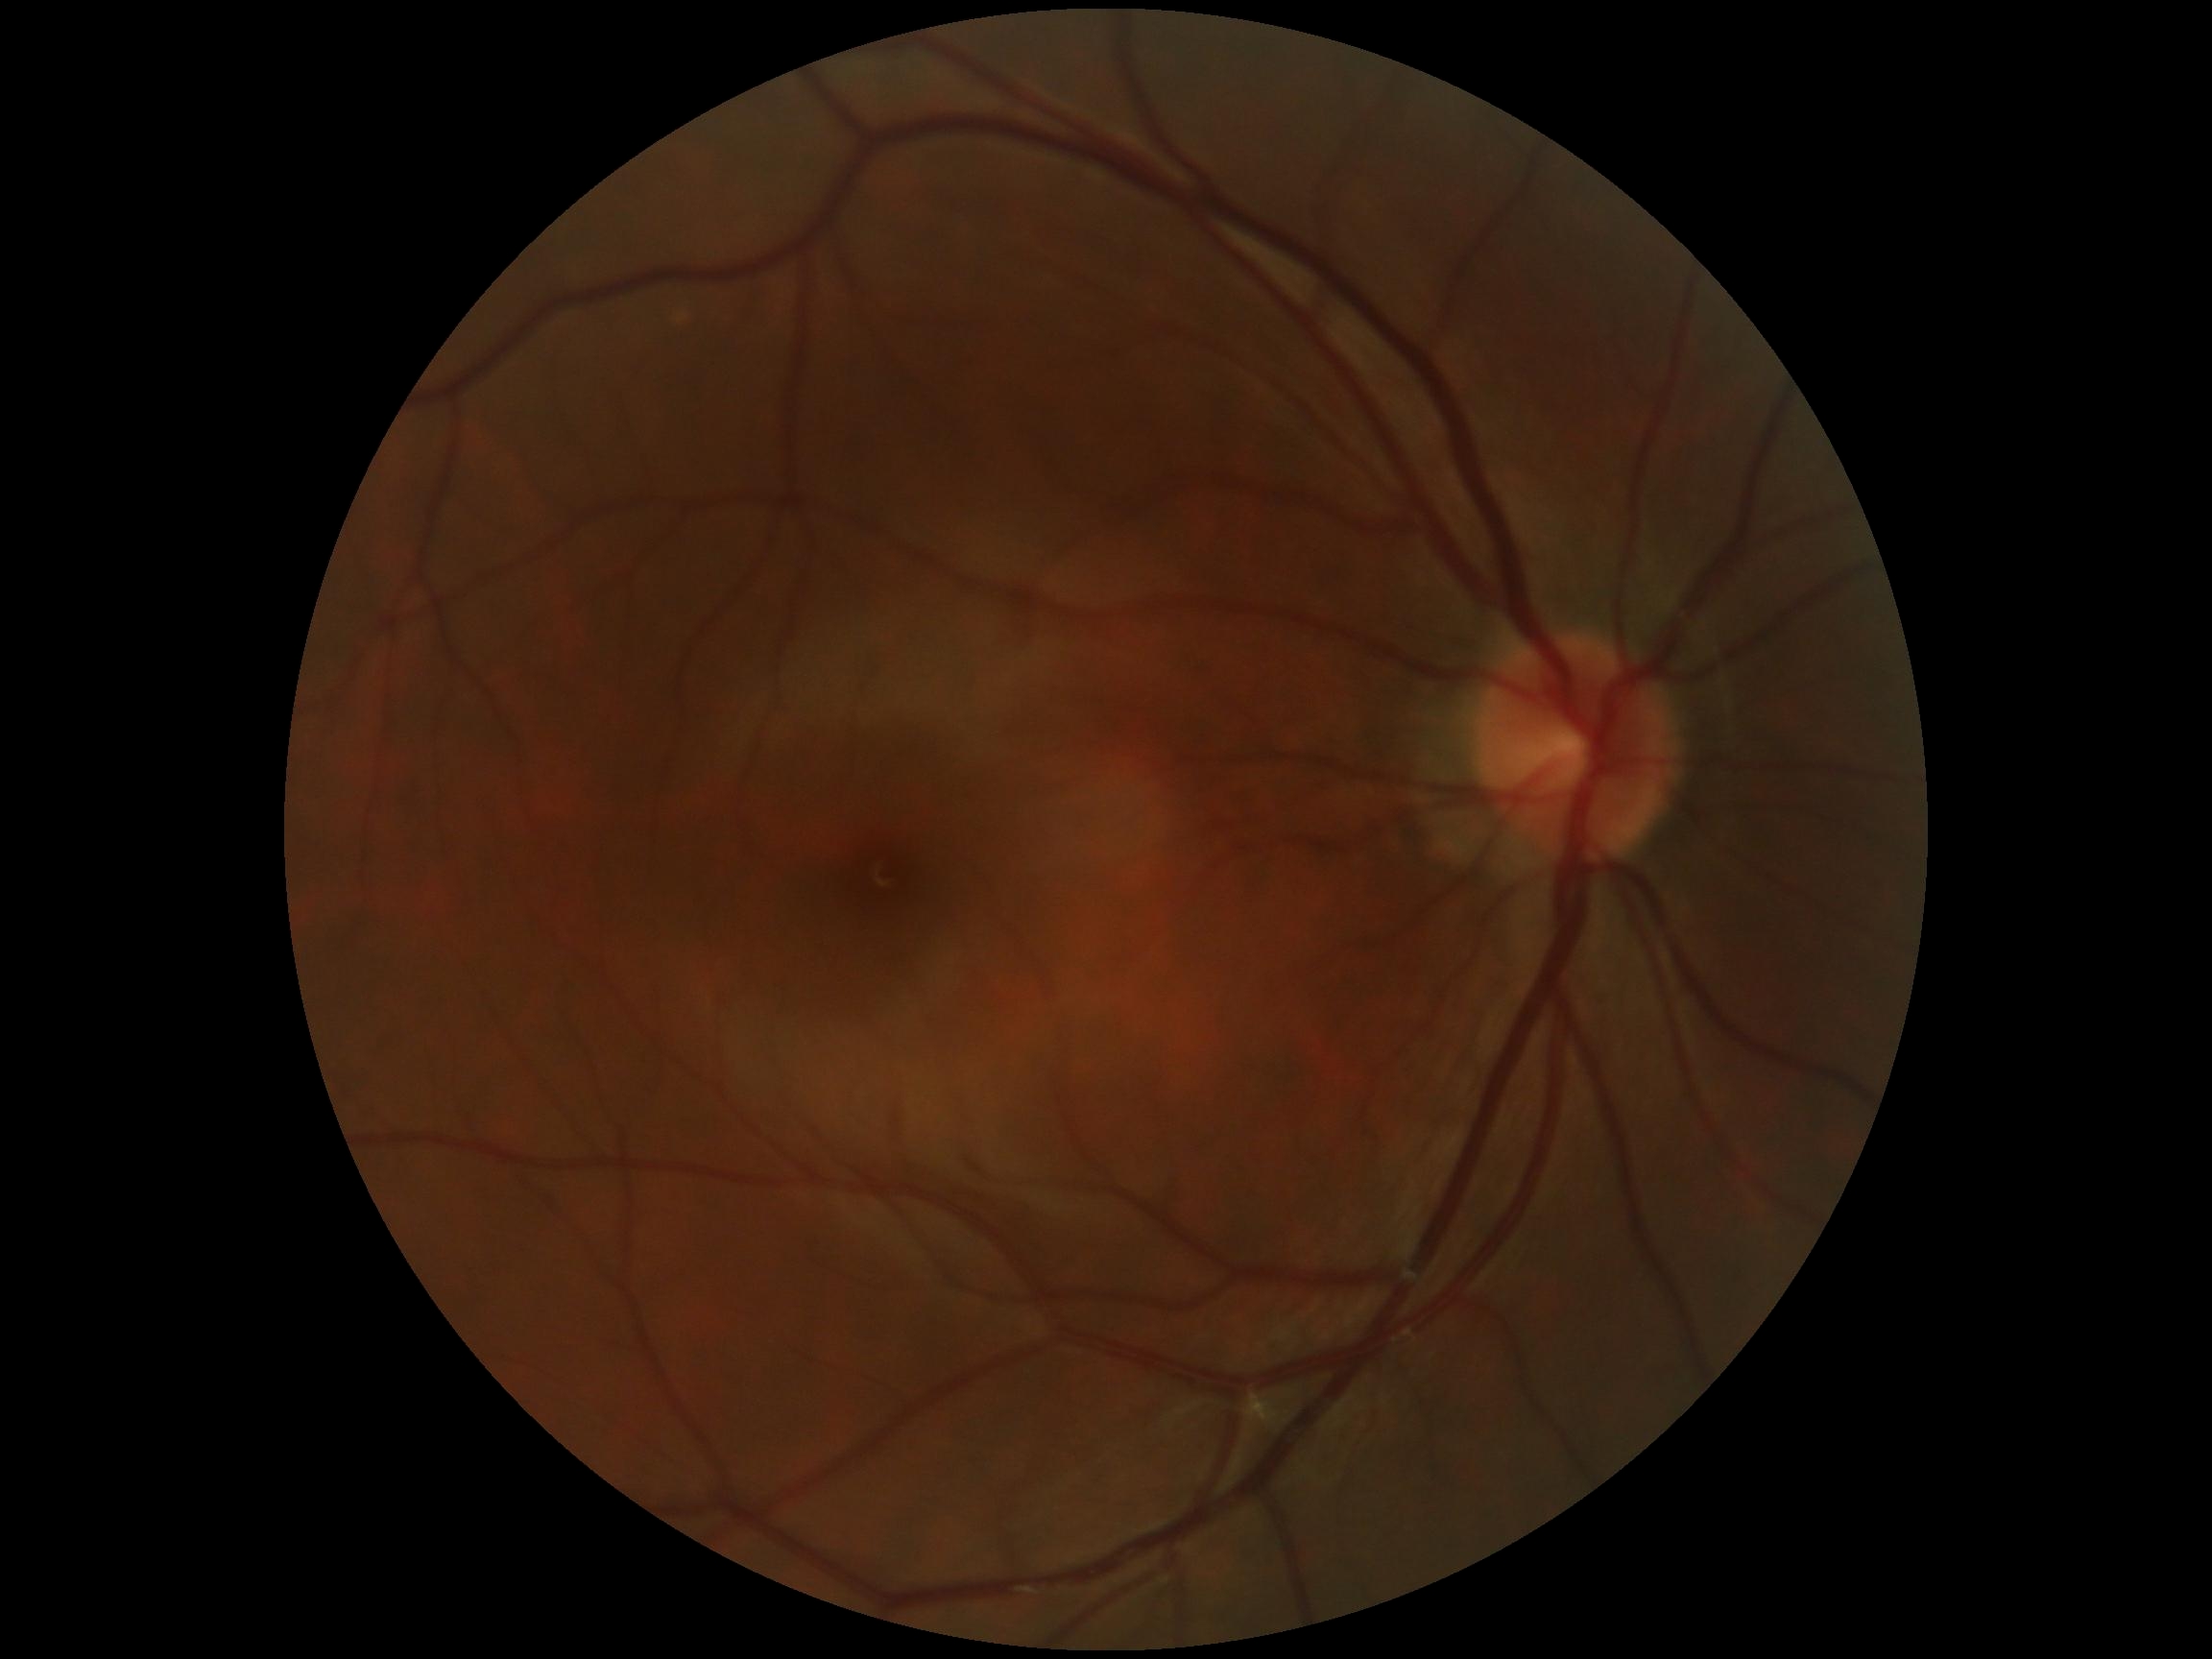 No DR findings.
Retinopathy grade: 0/4.